Wide-field fundus image from infant ROP screening. 640 x 480 pixels. Camera: Clarity RetCam 3 (130° FOV) — 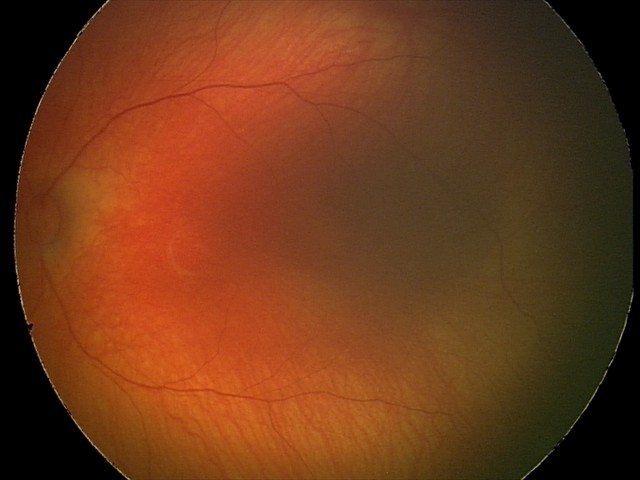

Screening diagnosis: normal retinal appearance.